Diabetic retinopathy graded by the modified Davis classification; acquired with a NIDEK AFC-230 — 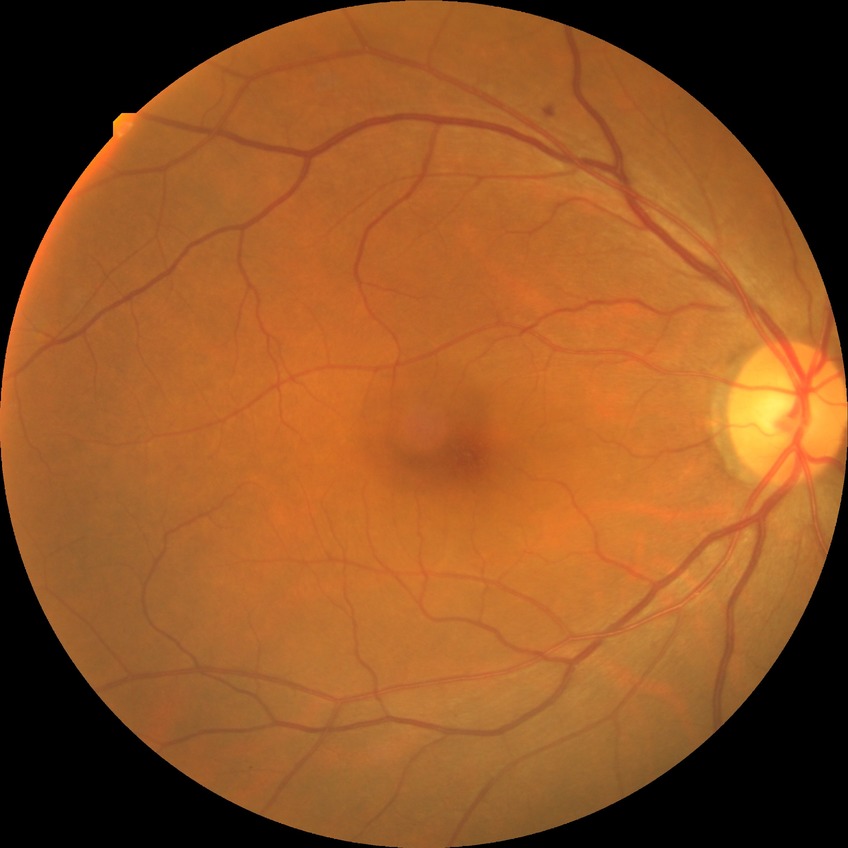 davis_grade: simple diabetic retinopathy
proliferative_class: non-proliferative diabetic retinopathy